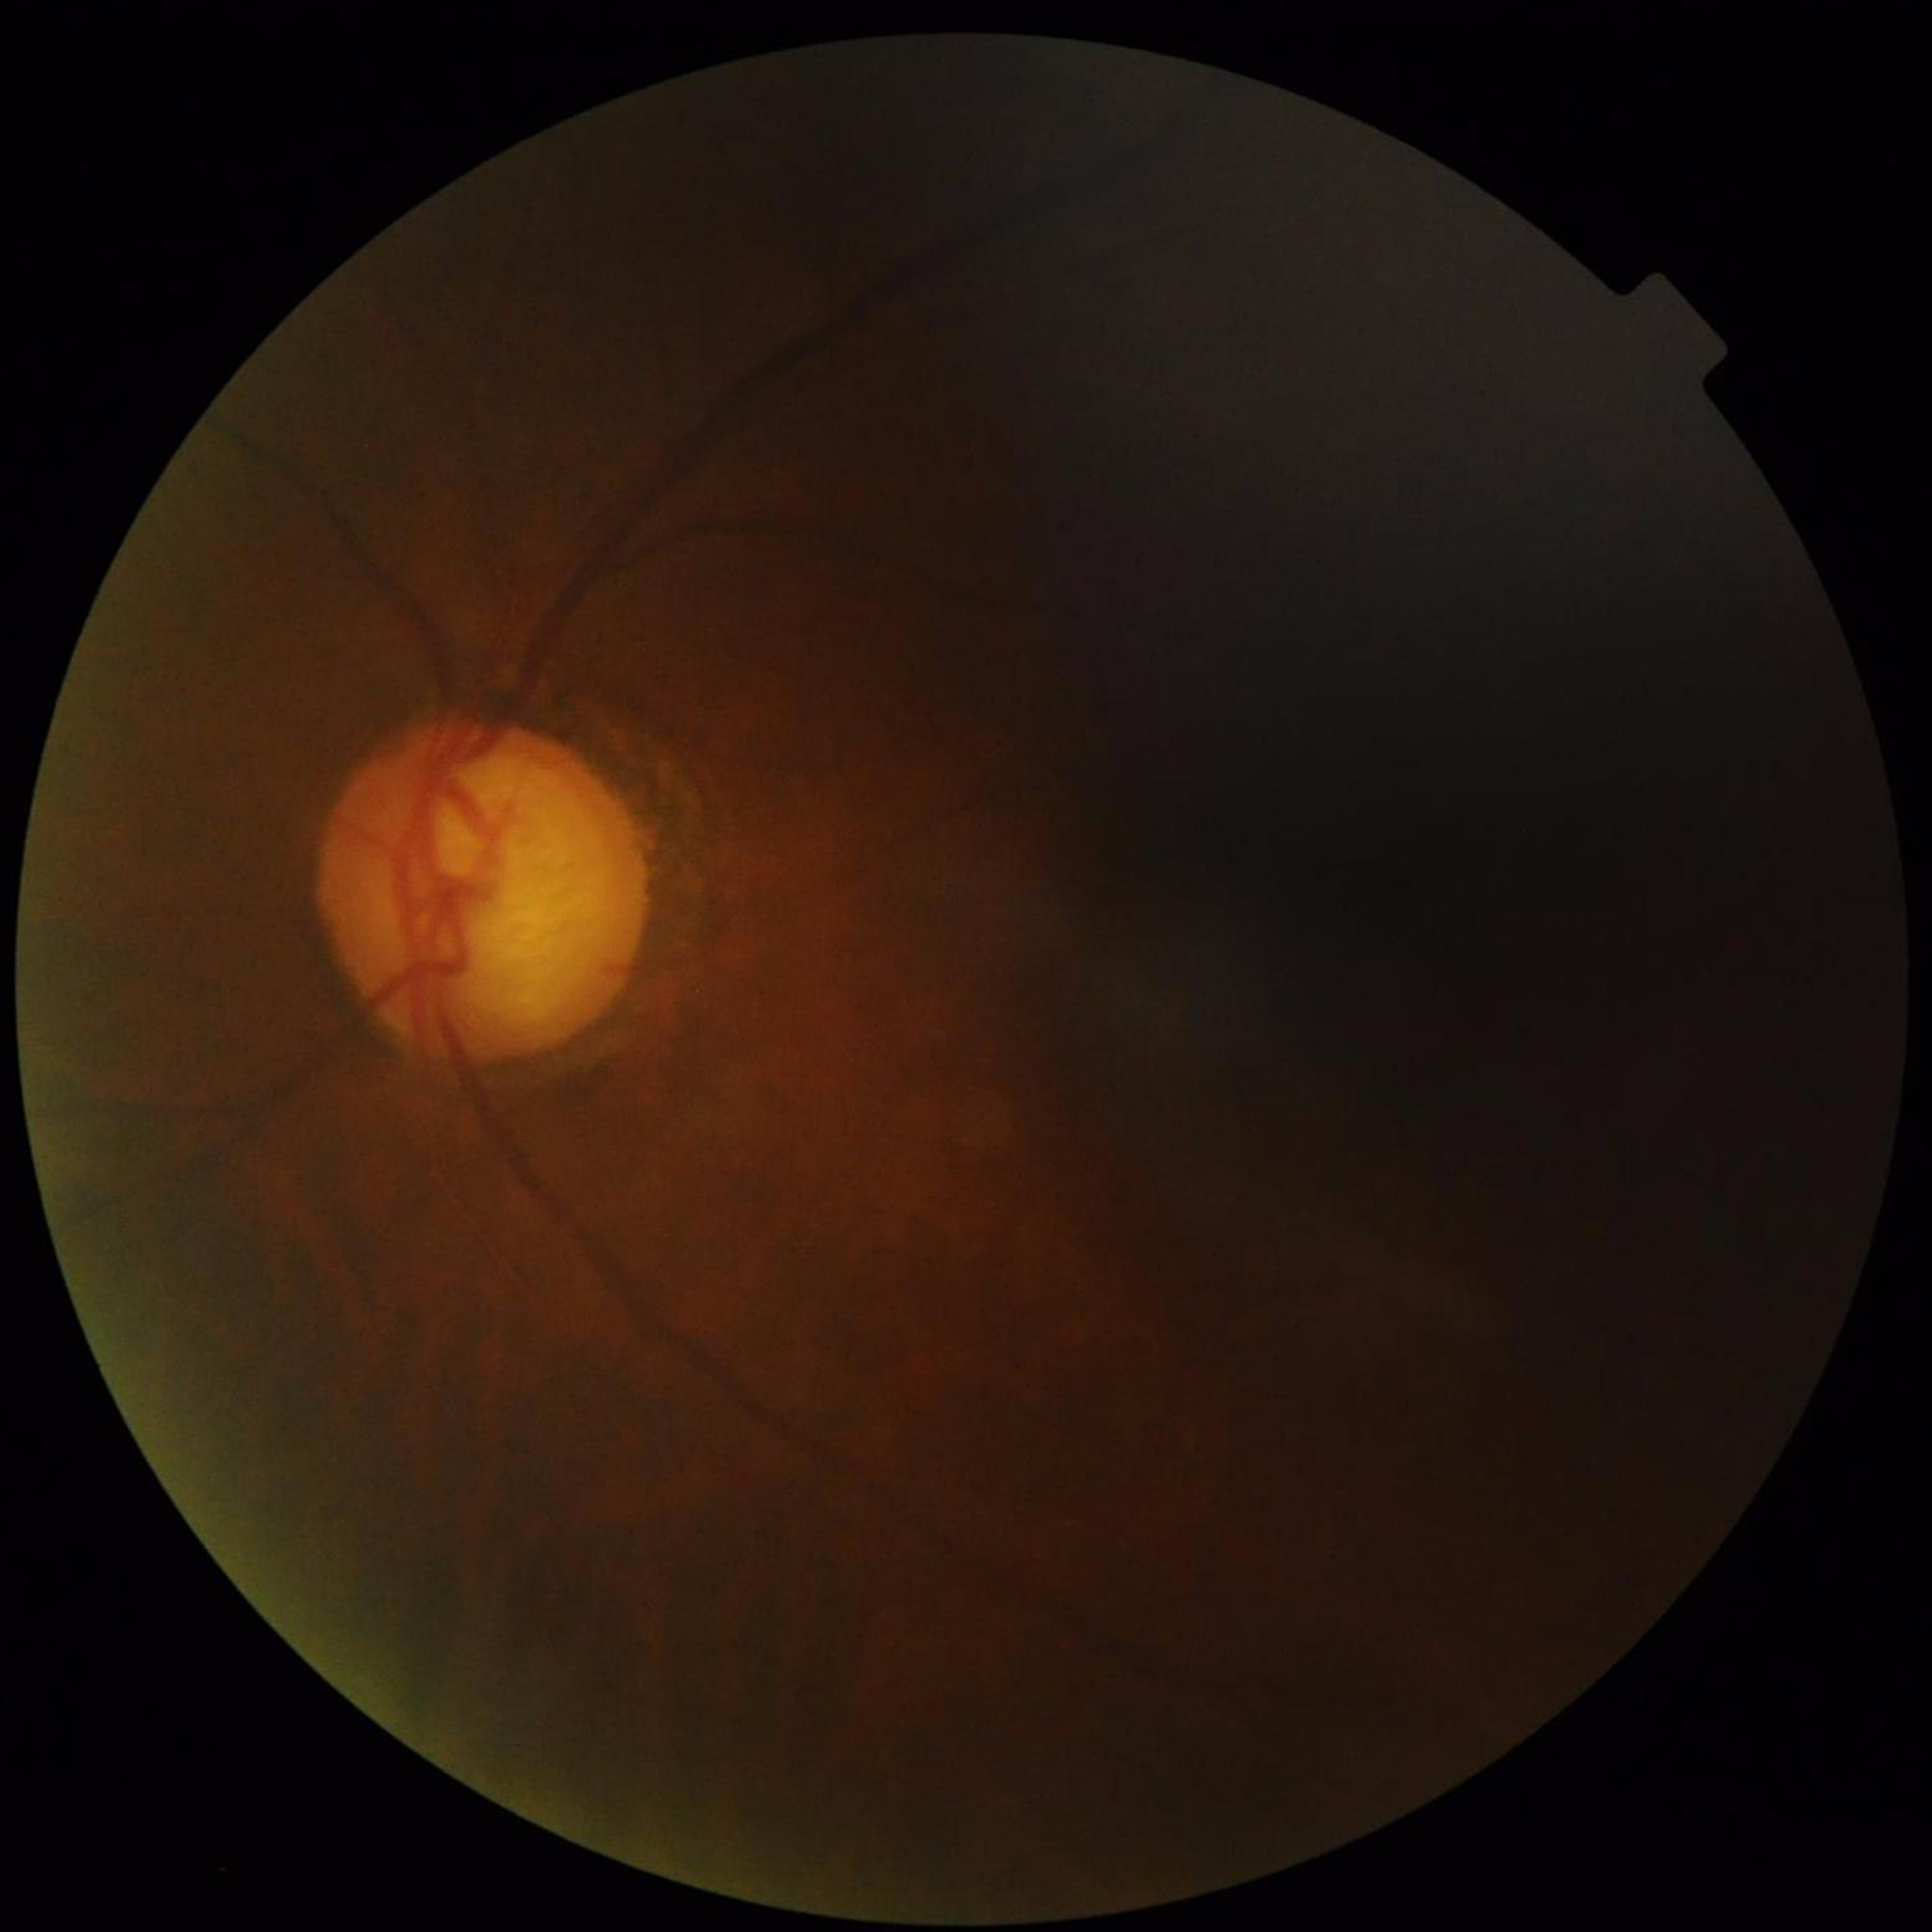
The patient was diagnosed with glaucoma.
Quality assessment: issues noted — blur, illumination/color distortion, low contrast.